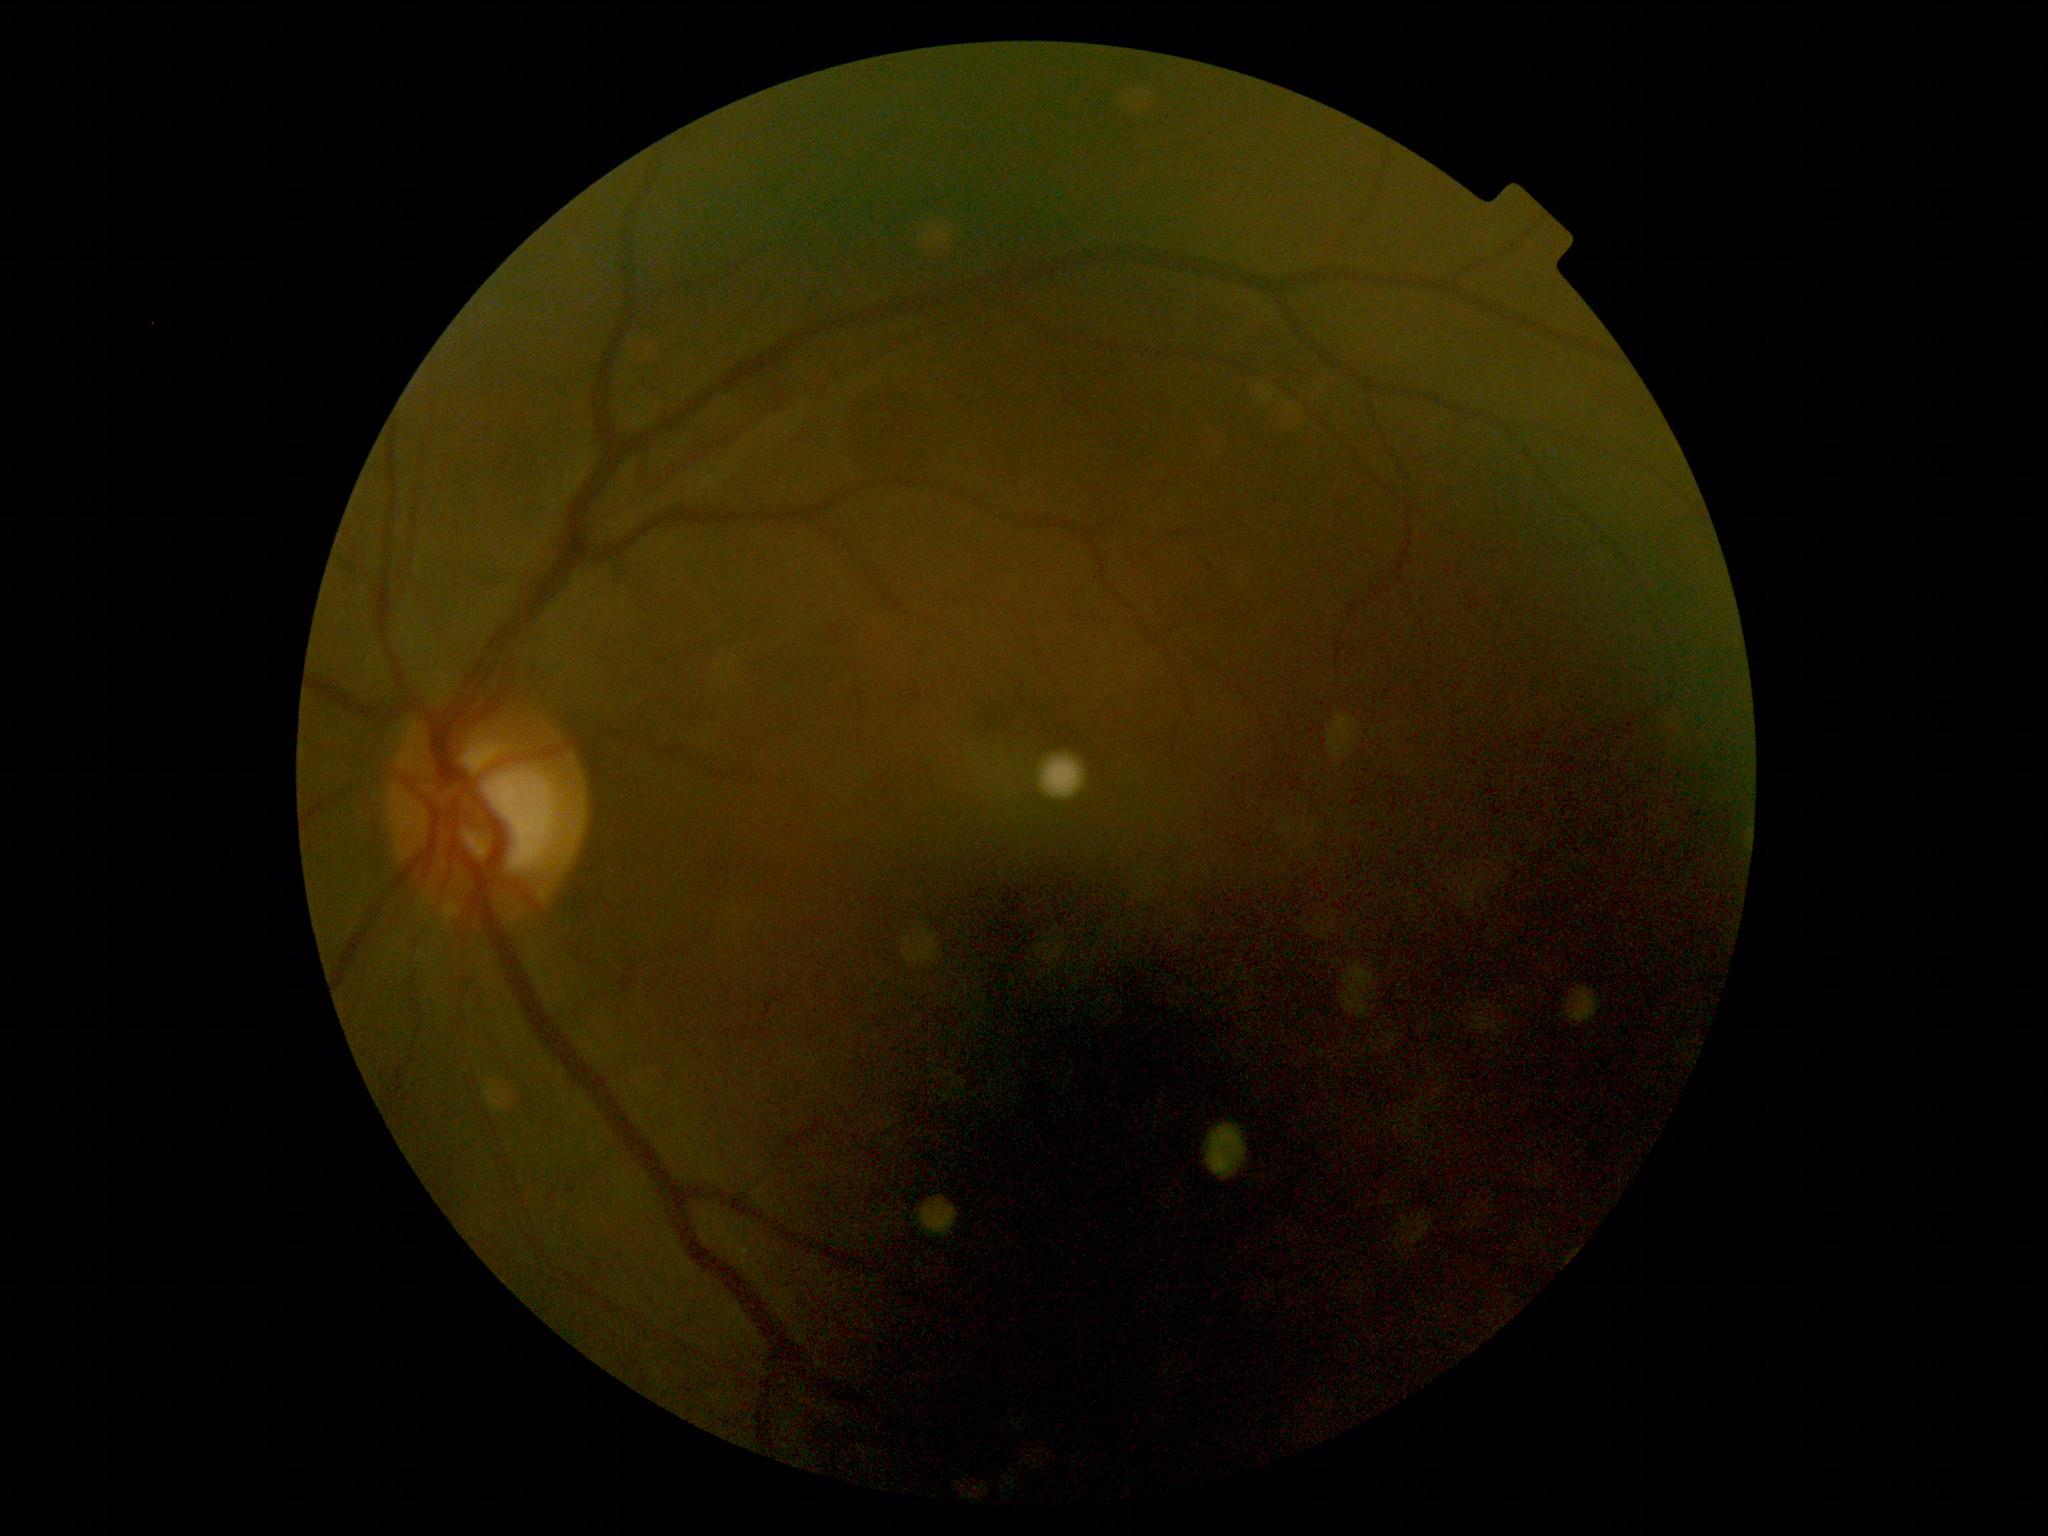 Diabetic retinopathy (DR): 0 — no visible signs of diabetic retinopathy.